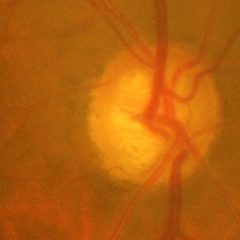
Q: Does this eye have glaucoma?
A: Yes — advanced-stage glaucoma. (Criteria: near-total cupping of the optic nerve head, with or without severe visual field loss within the central 10 degrees of fixation.)